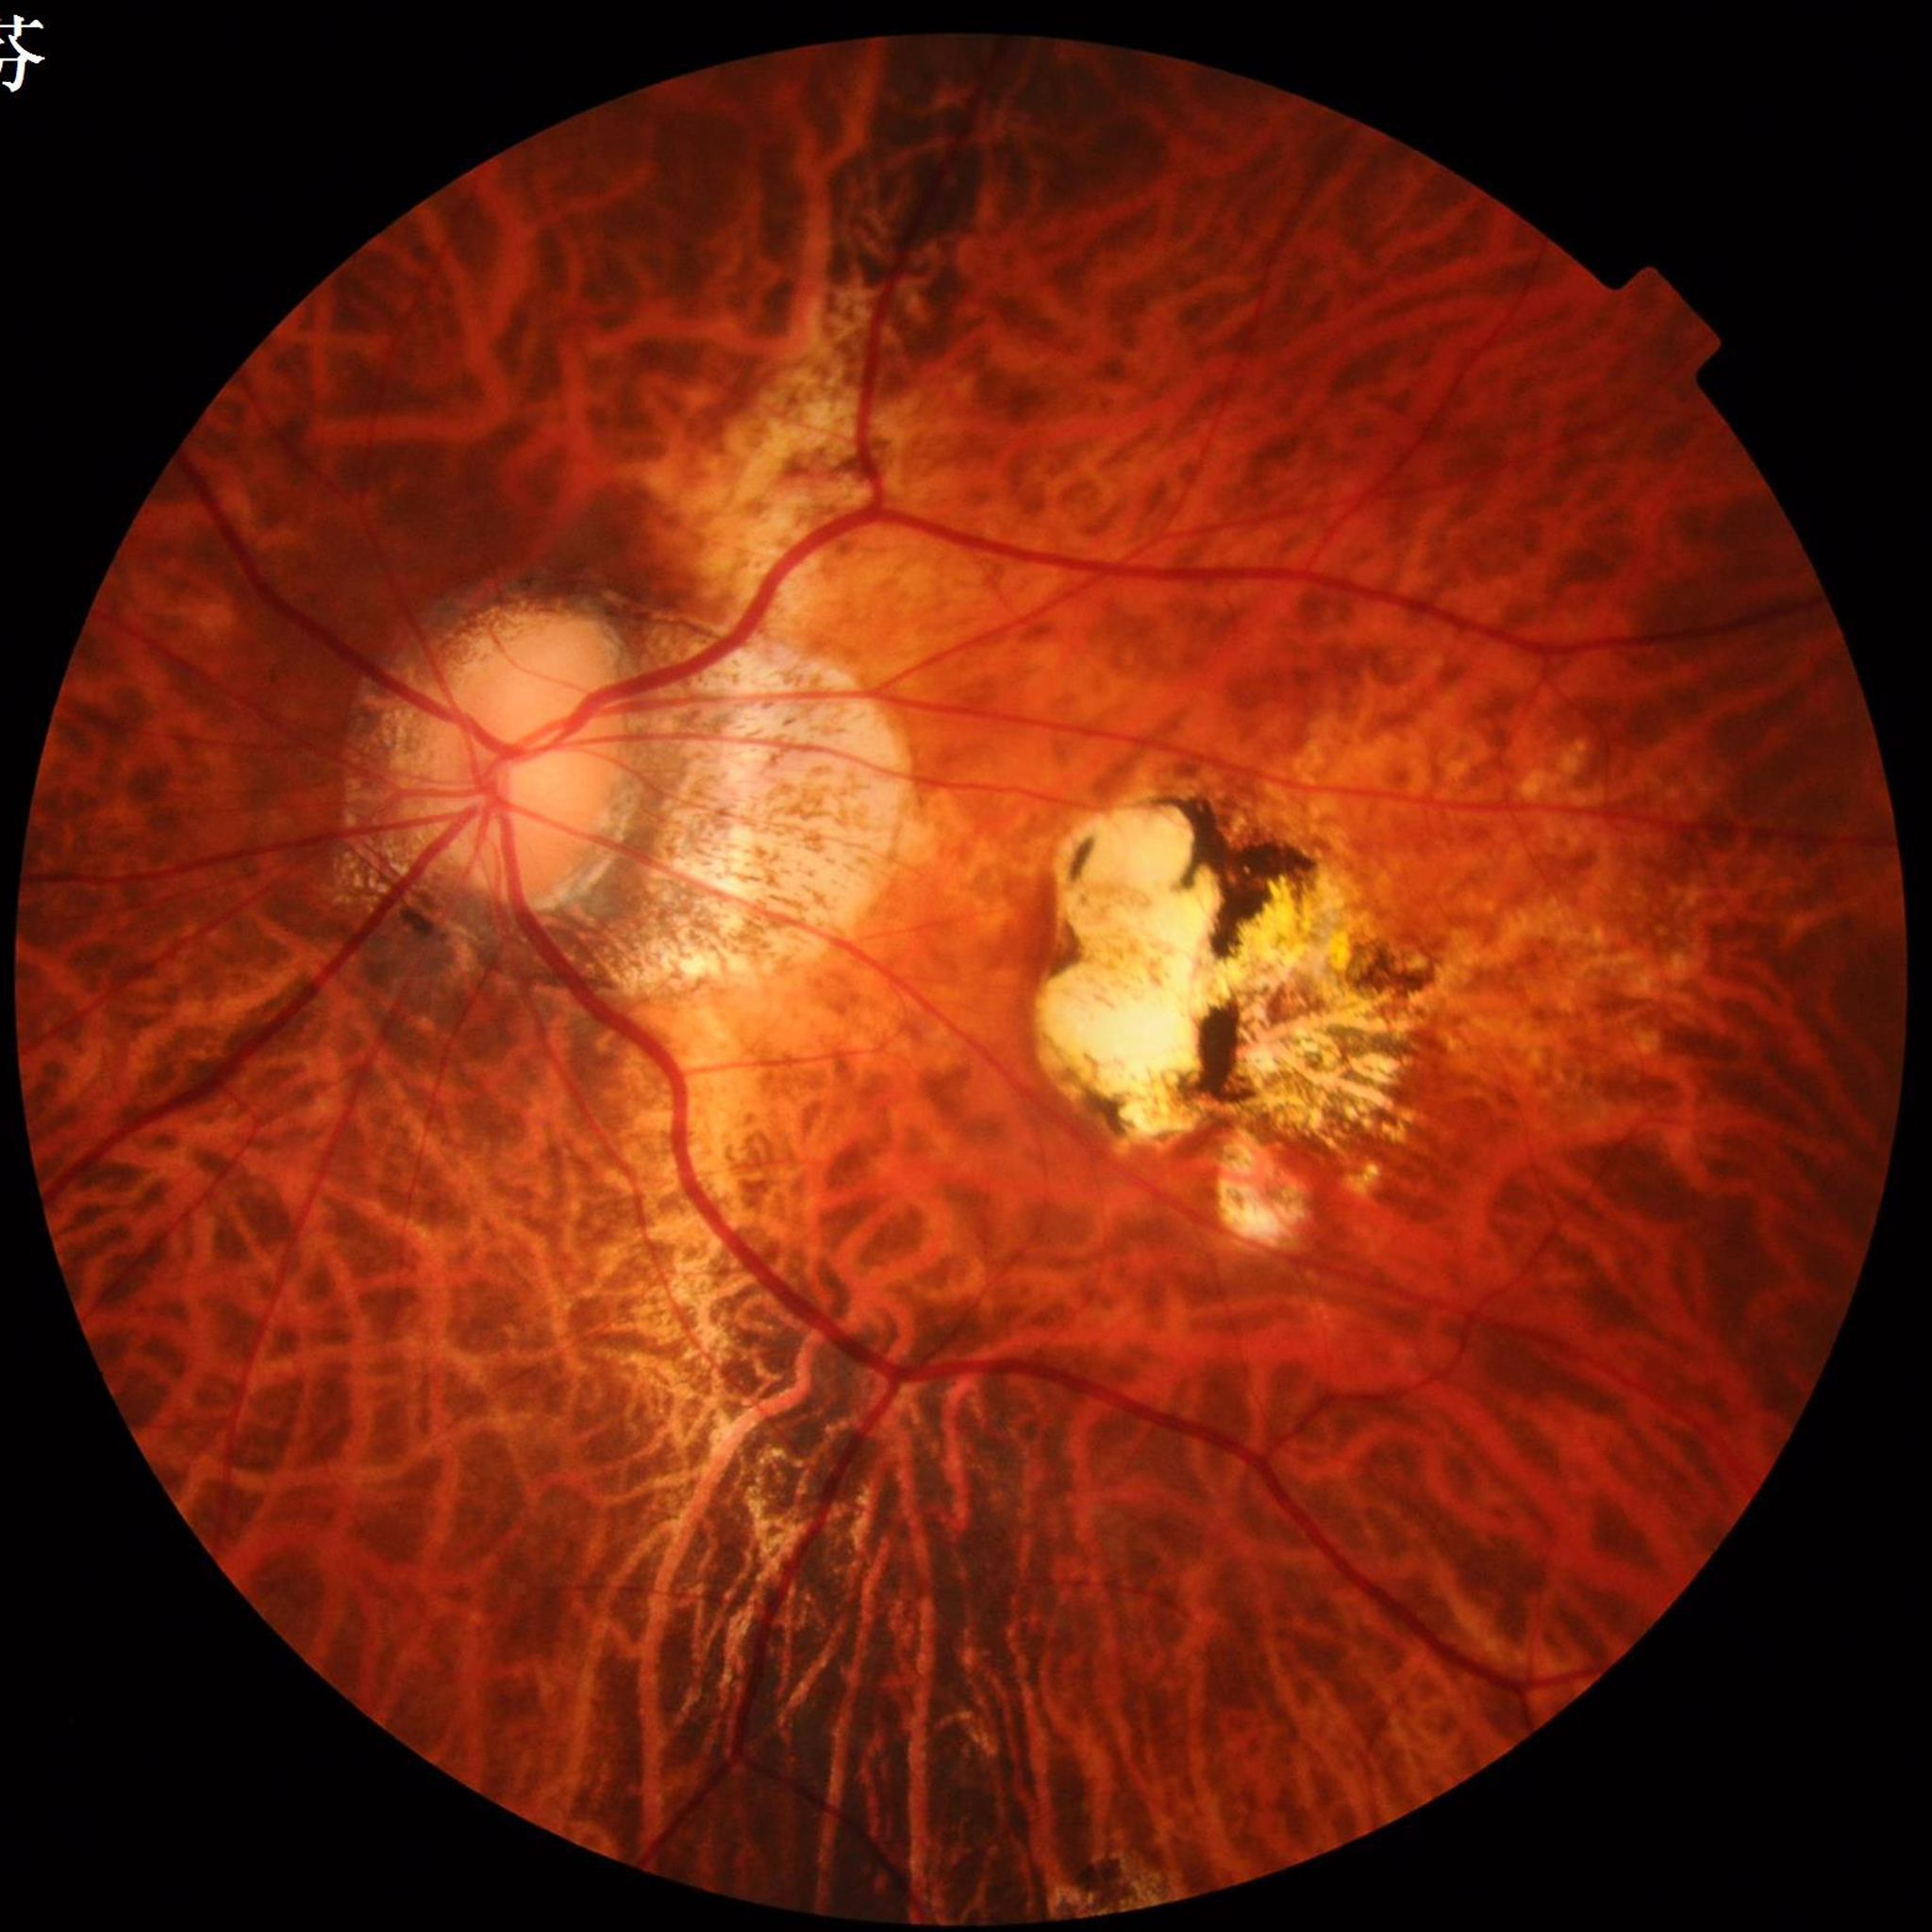   image_quality: satisfactory
  diagnosis: AMD